1240x1240. Wide-field fundus photograph from neonatal ROP screening:
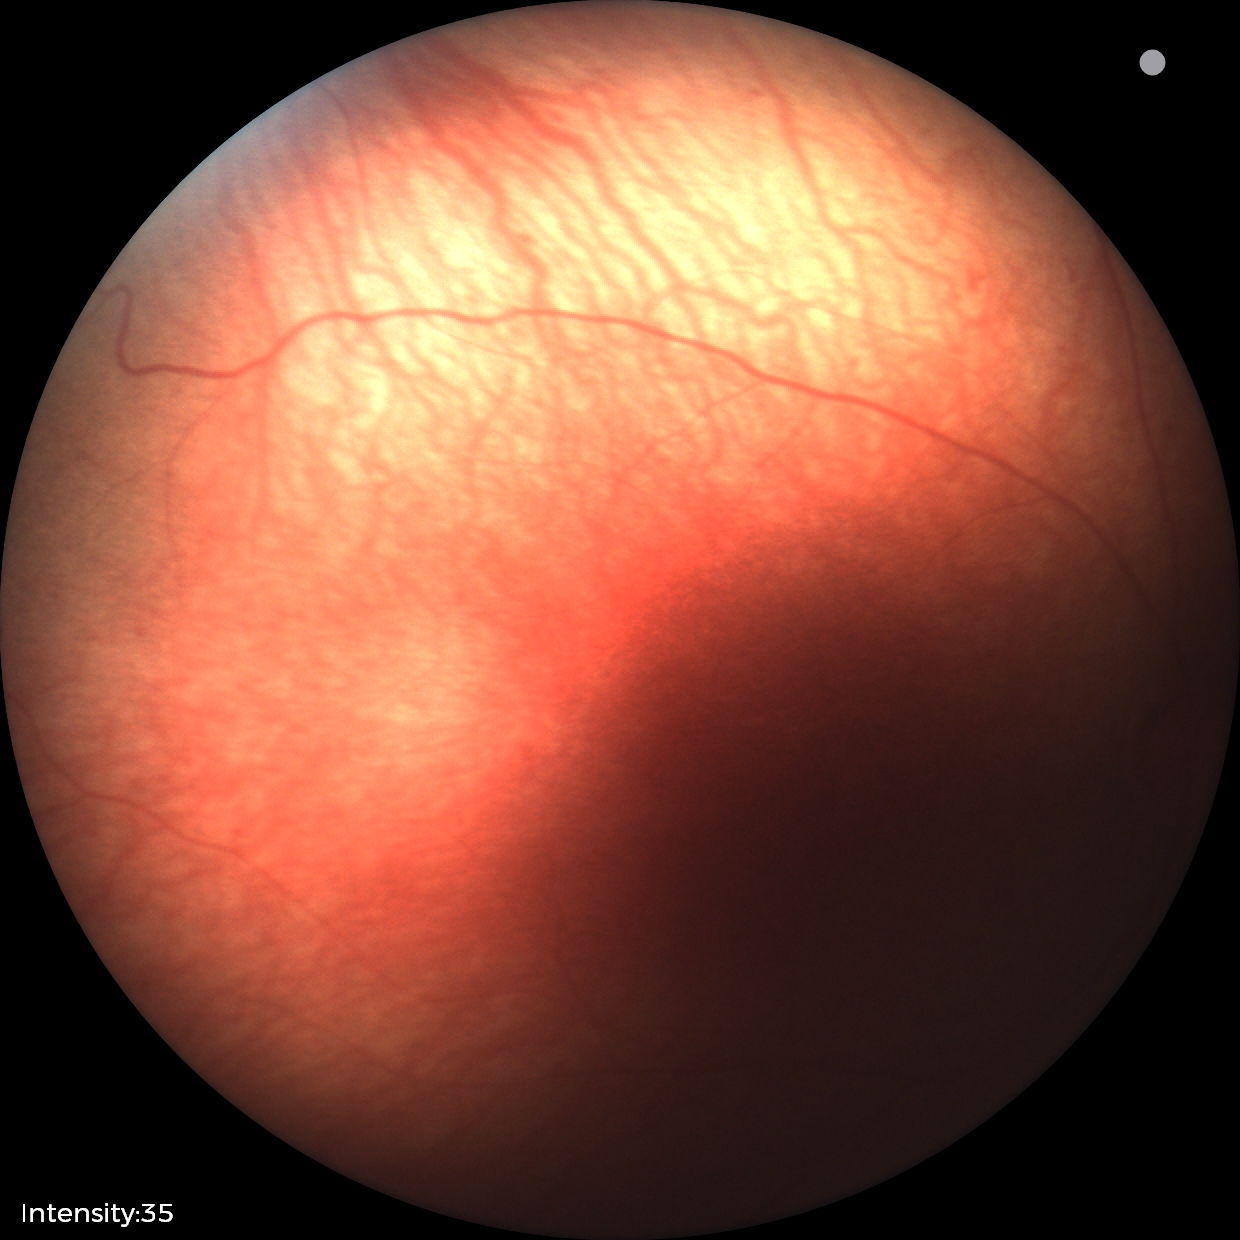 No plus disease.
Series diagnosed as retinopathy of prematurity stage 1.